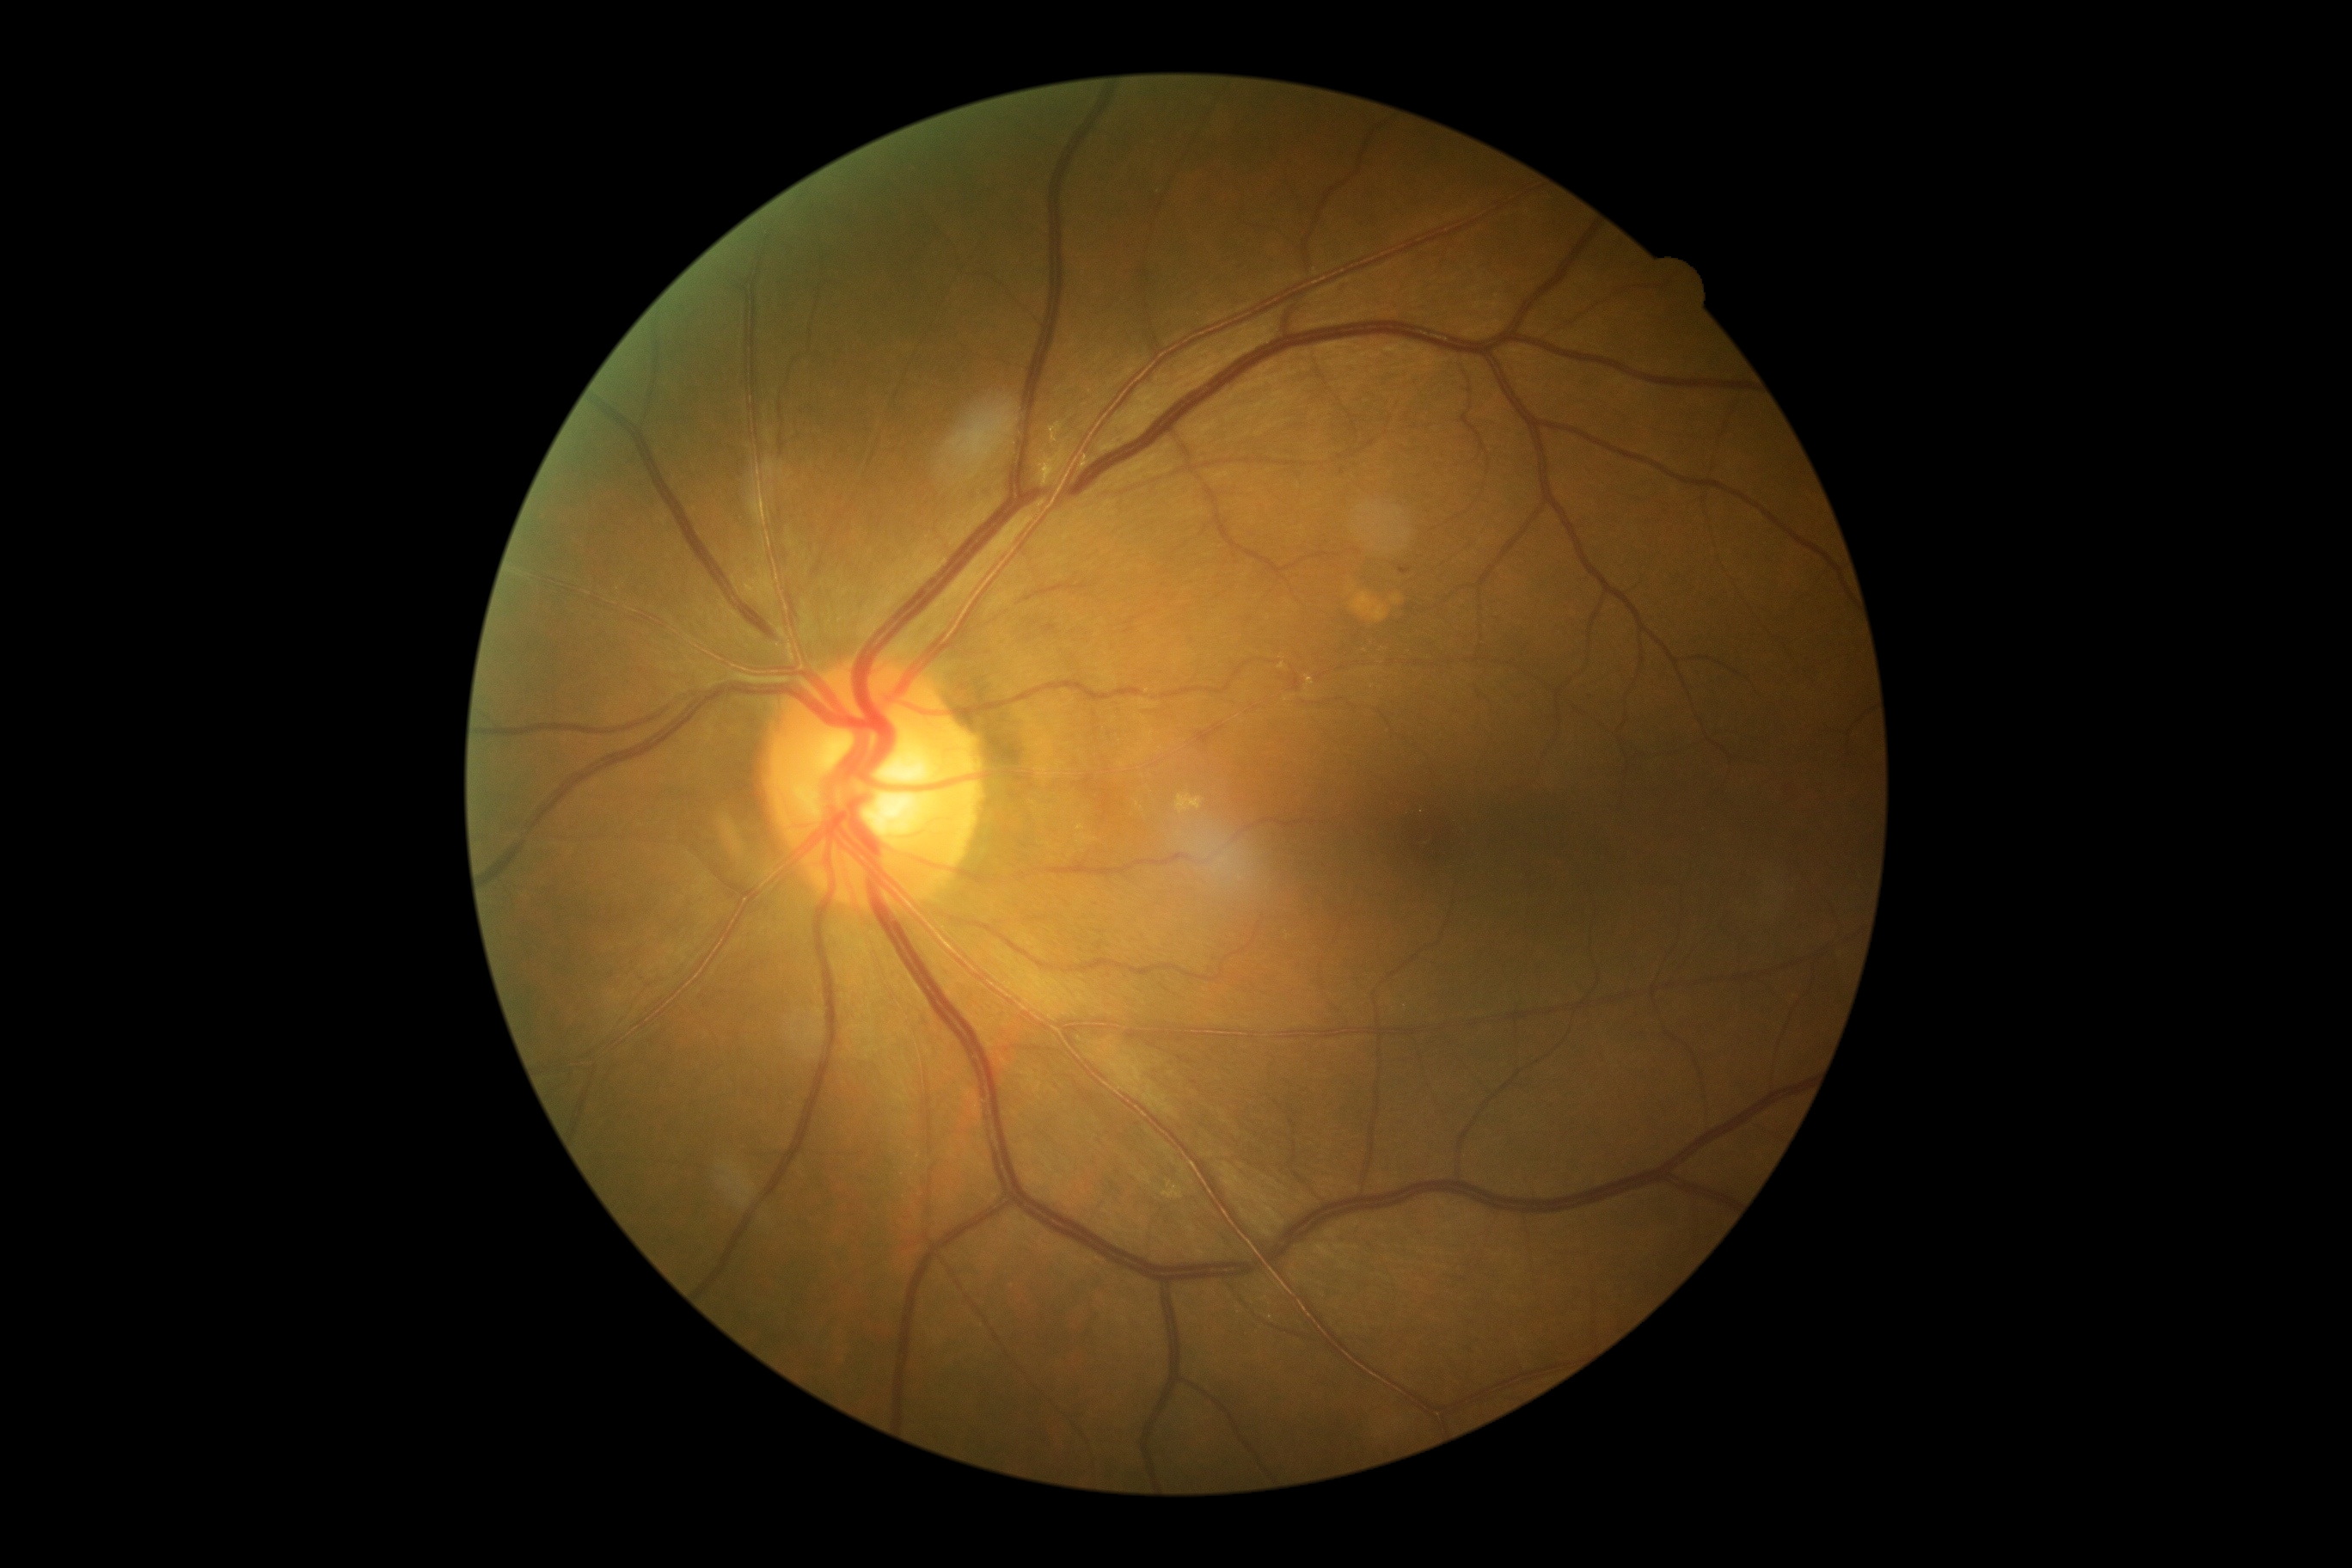

Diabetic retinopathy (DR): moderate non-proliferative diabetic retinopathy (grade 2)
hard exudates (EXs) = absent
soft exudates (SEs) = absent
hemorrhages (HEs) = x1=1399 y1=567 x2=1412 y2=575, x1=1777 y1=778 x2=1801 y2=800
microaneurysms (MAs) = absent